Wide-field fundus image from infant ROP screening
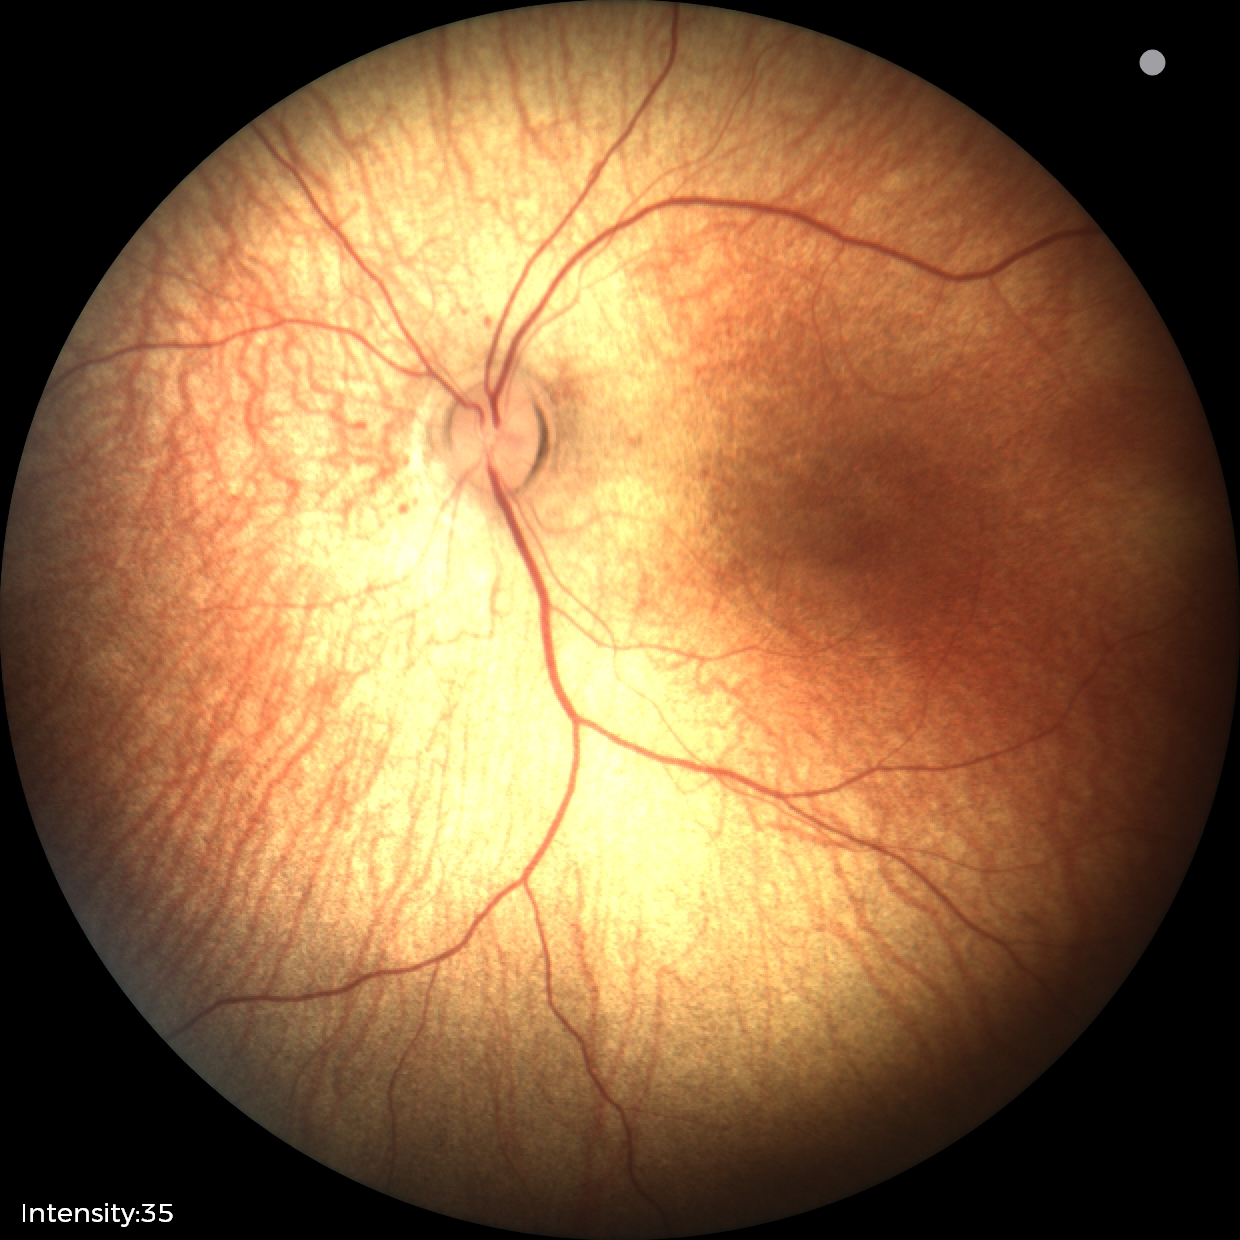

Screening examination with no abnormal retinal findings.